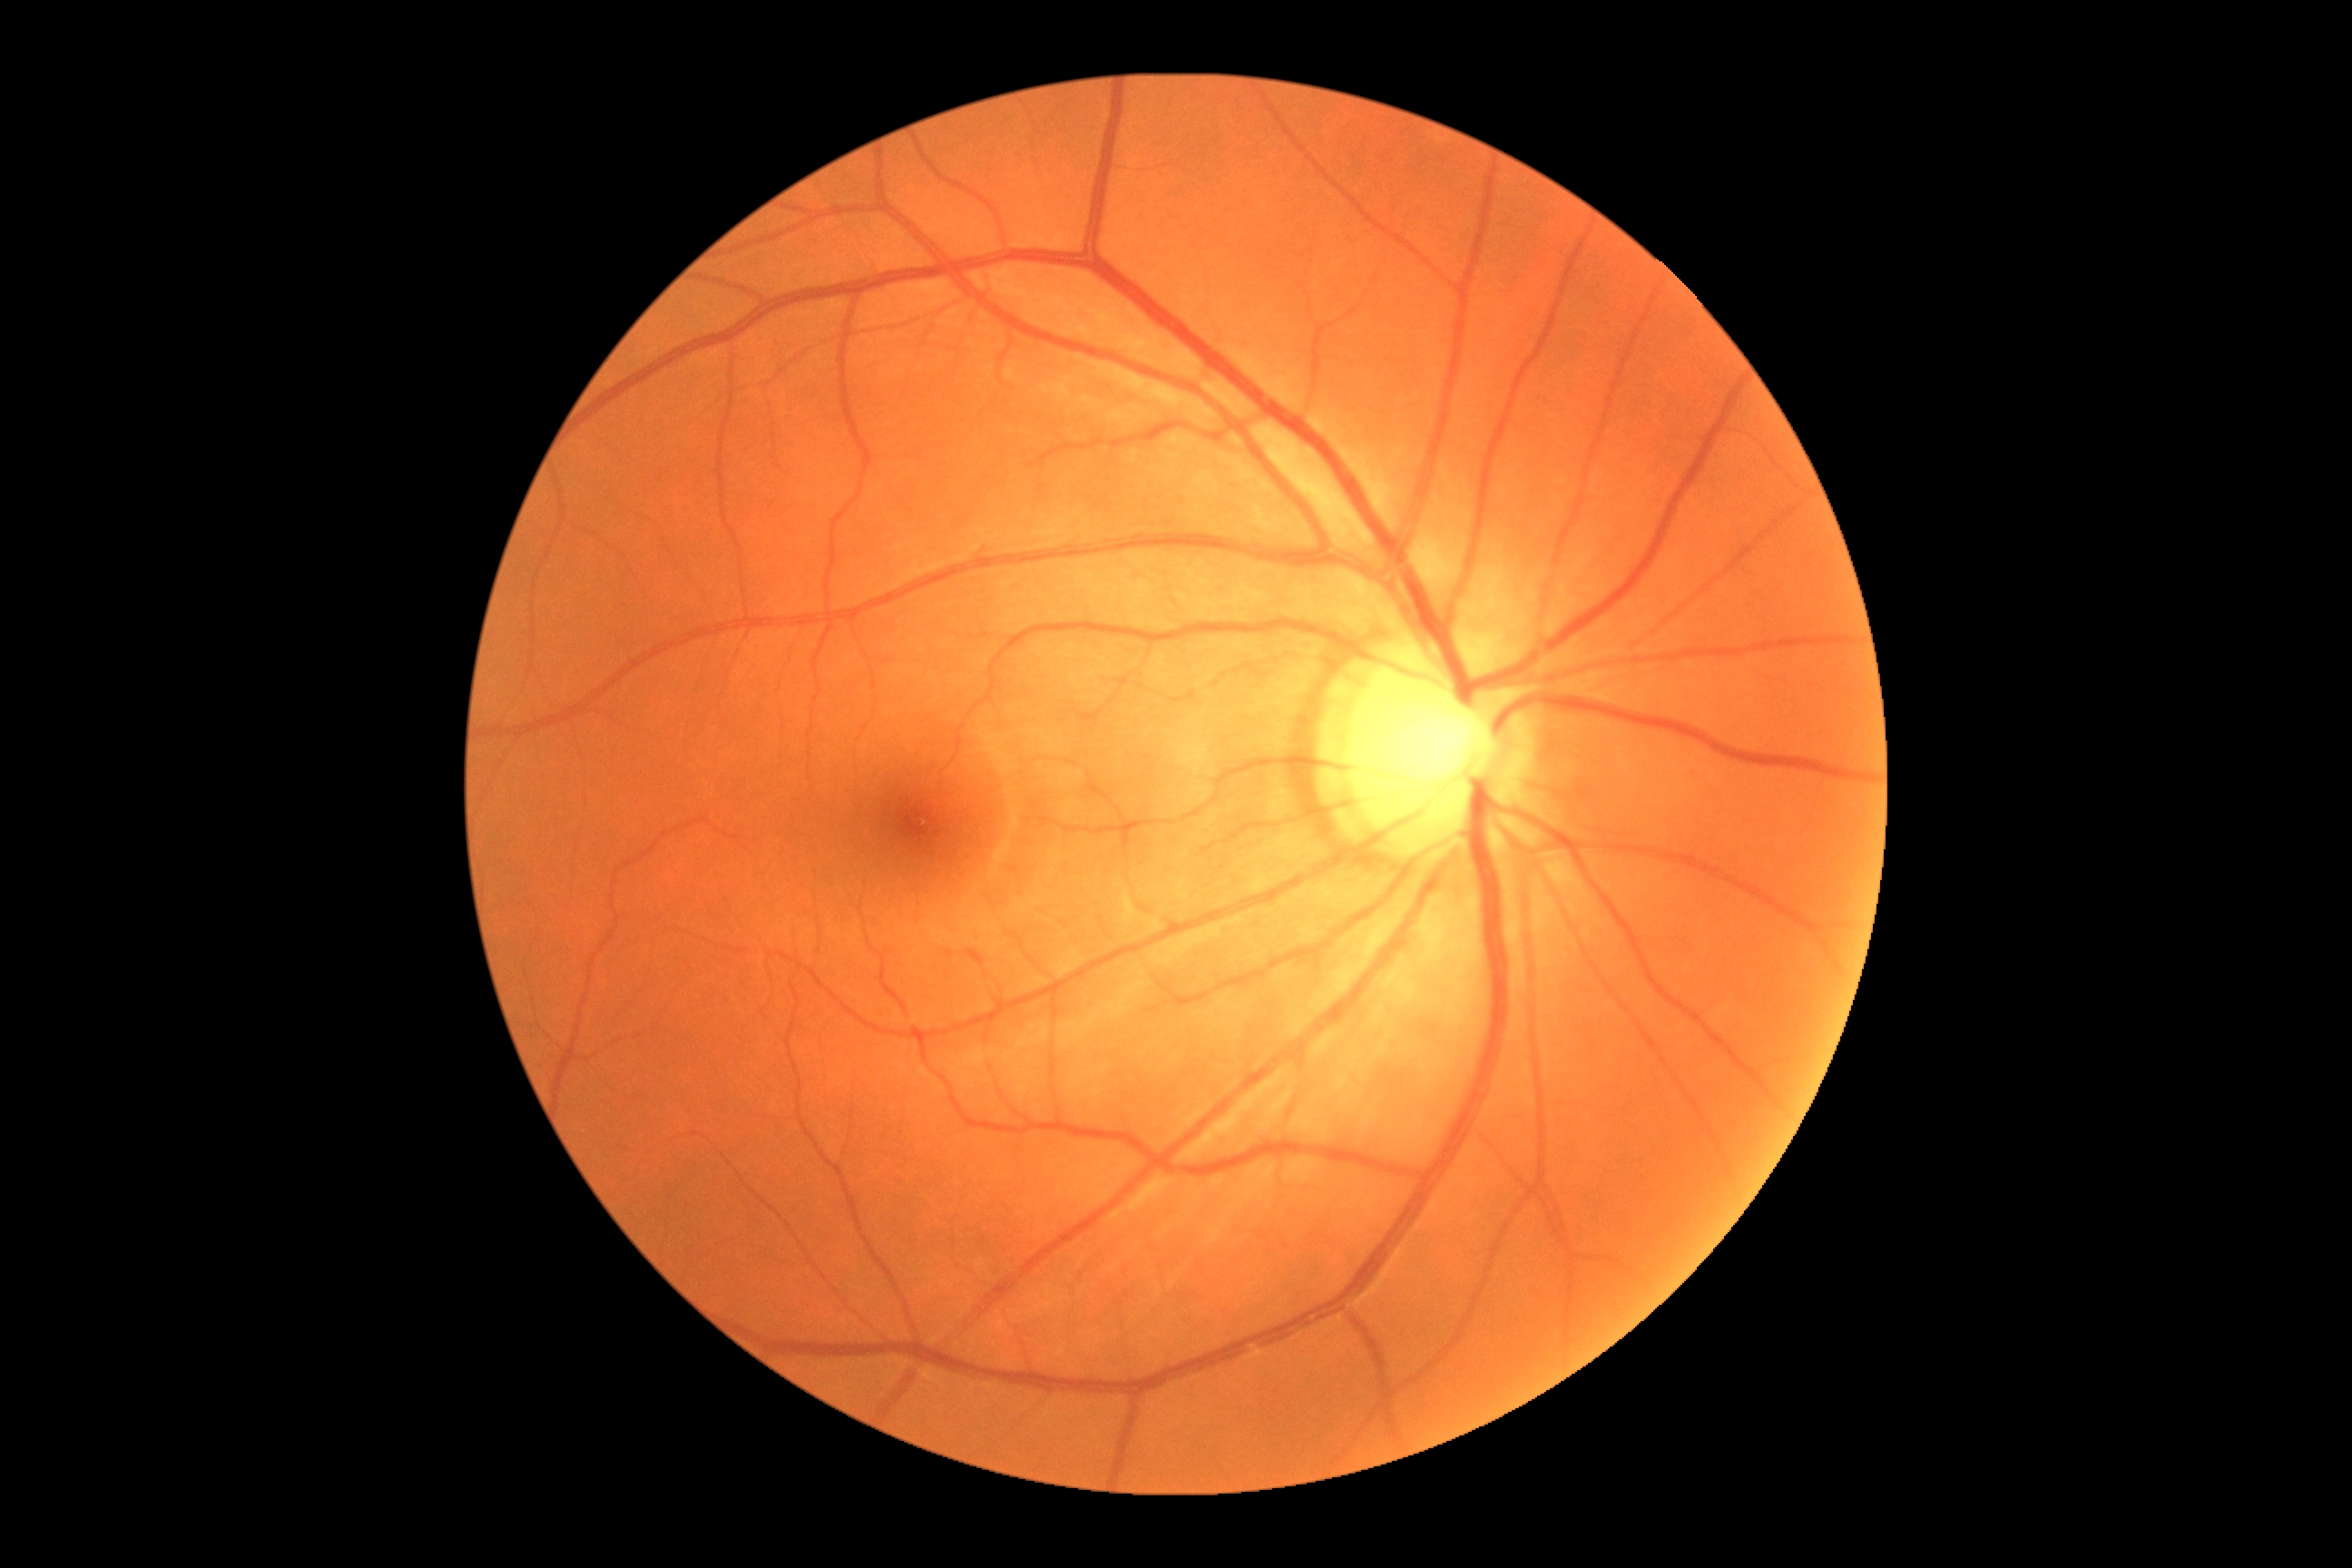
diabetic retinopathy (DR) = 0/4.